Wide-field contact fundus photograph of an infant · image size 1440x1080: 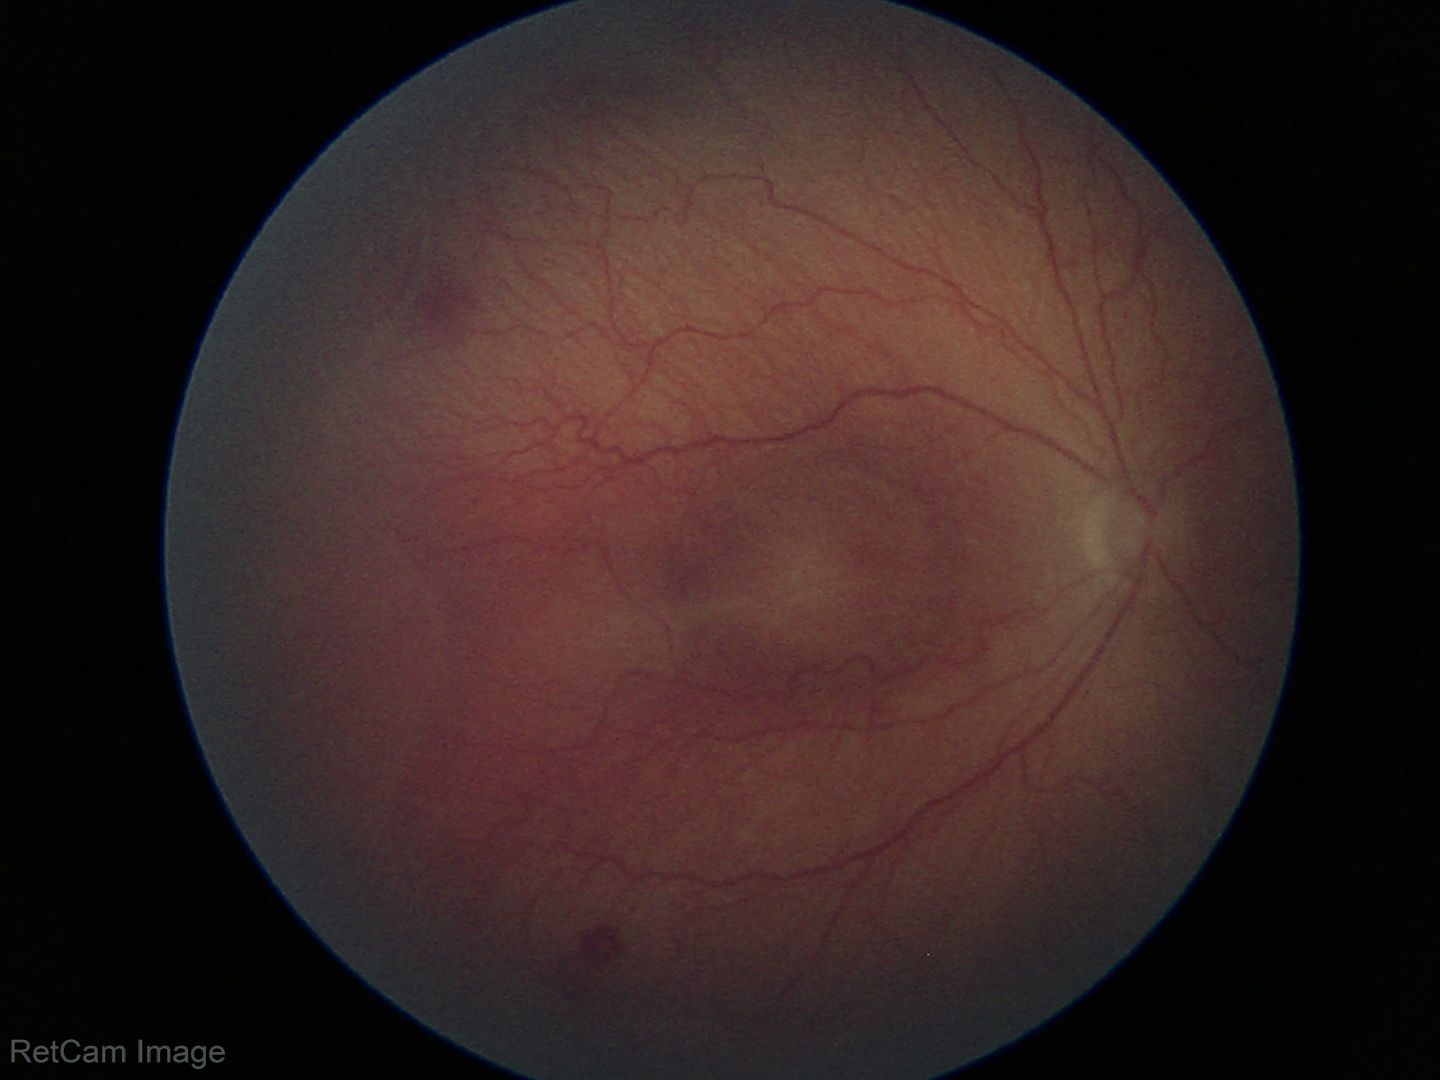

Assessment: ROP stage 2; no plus disease.